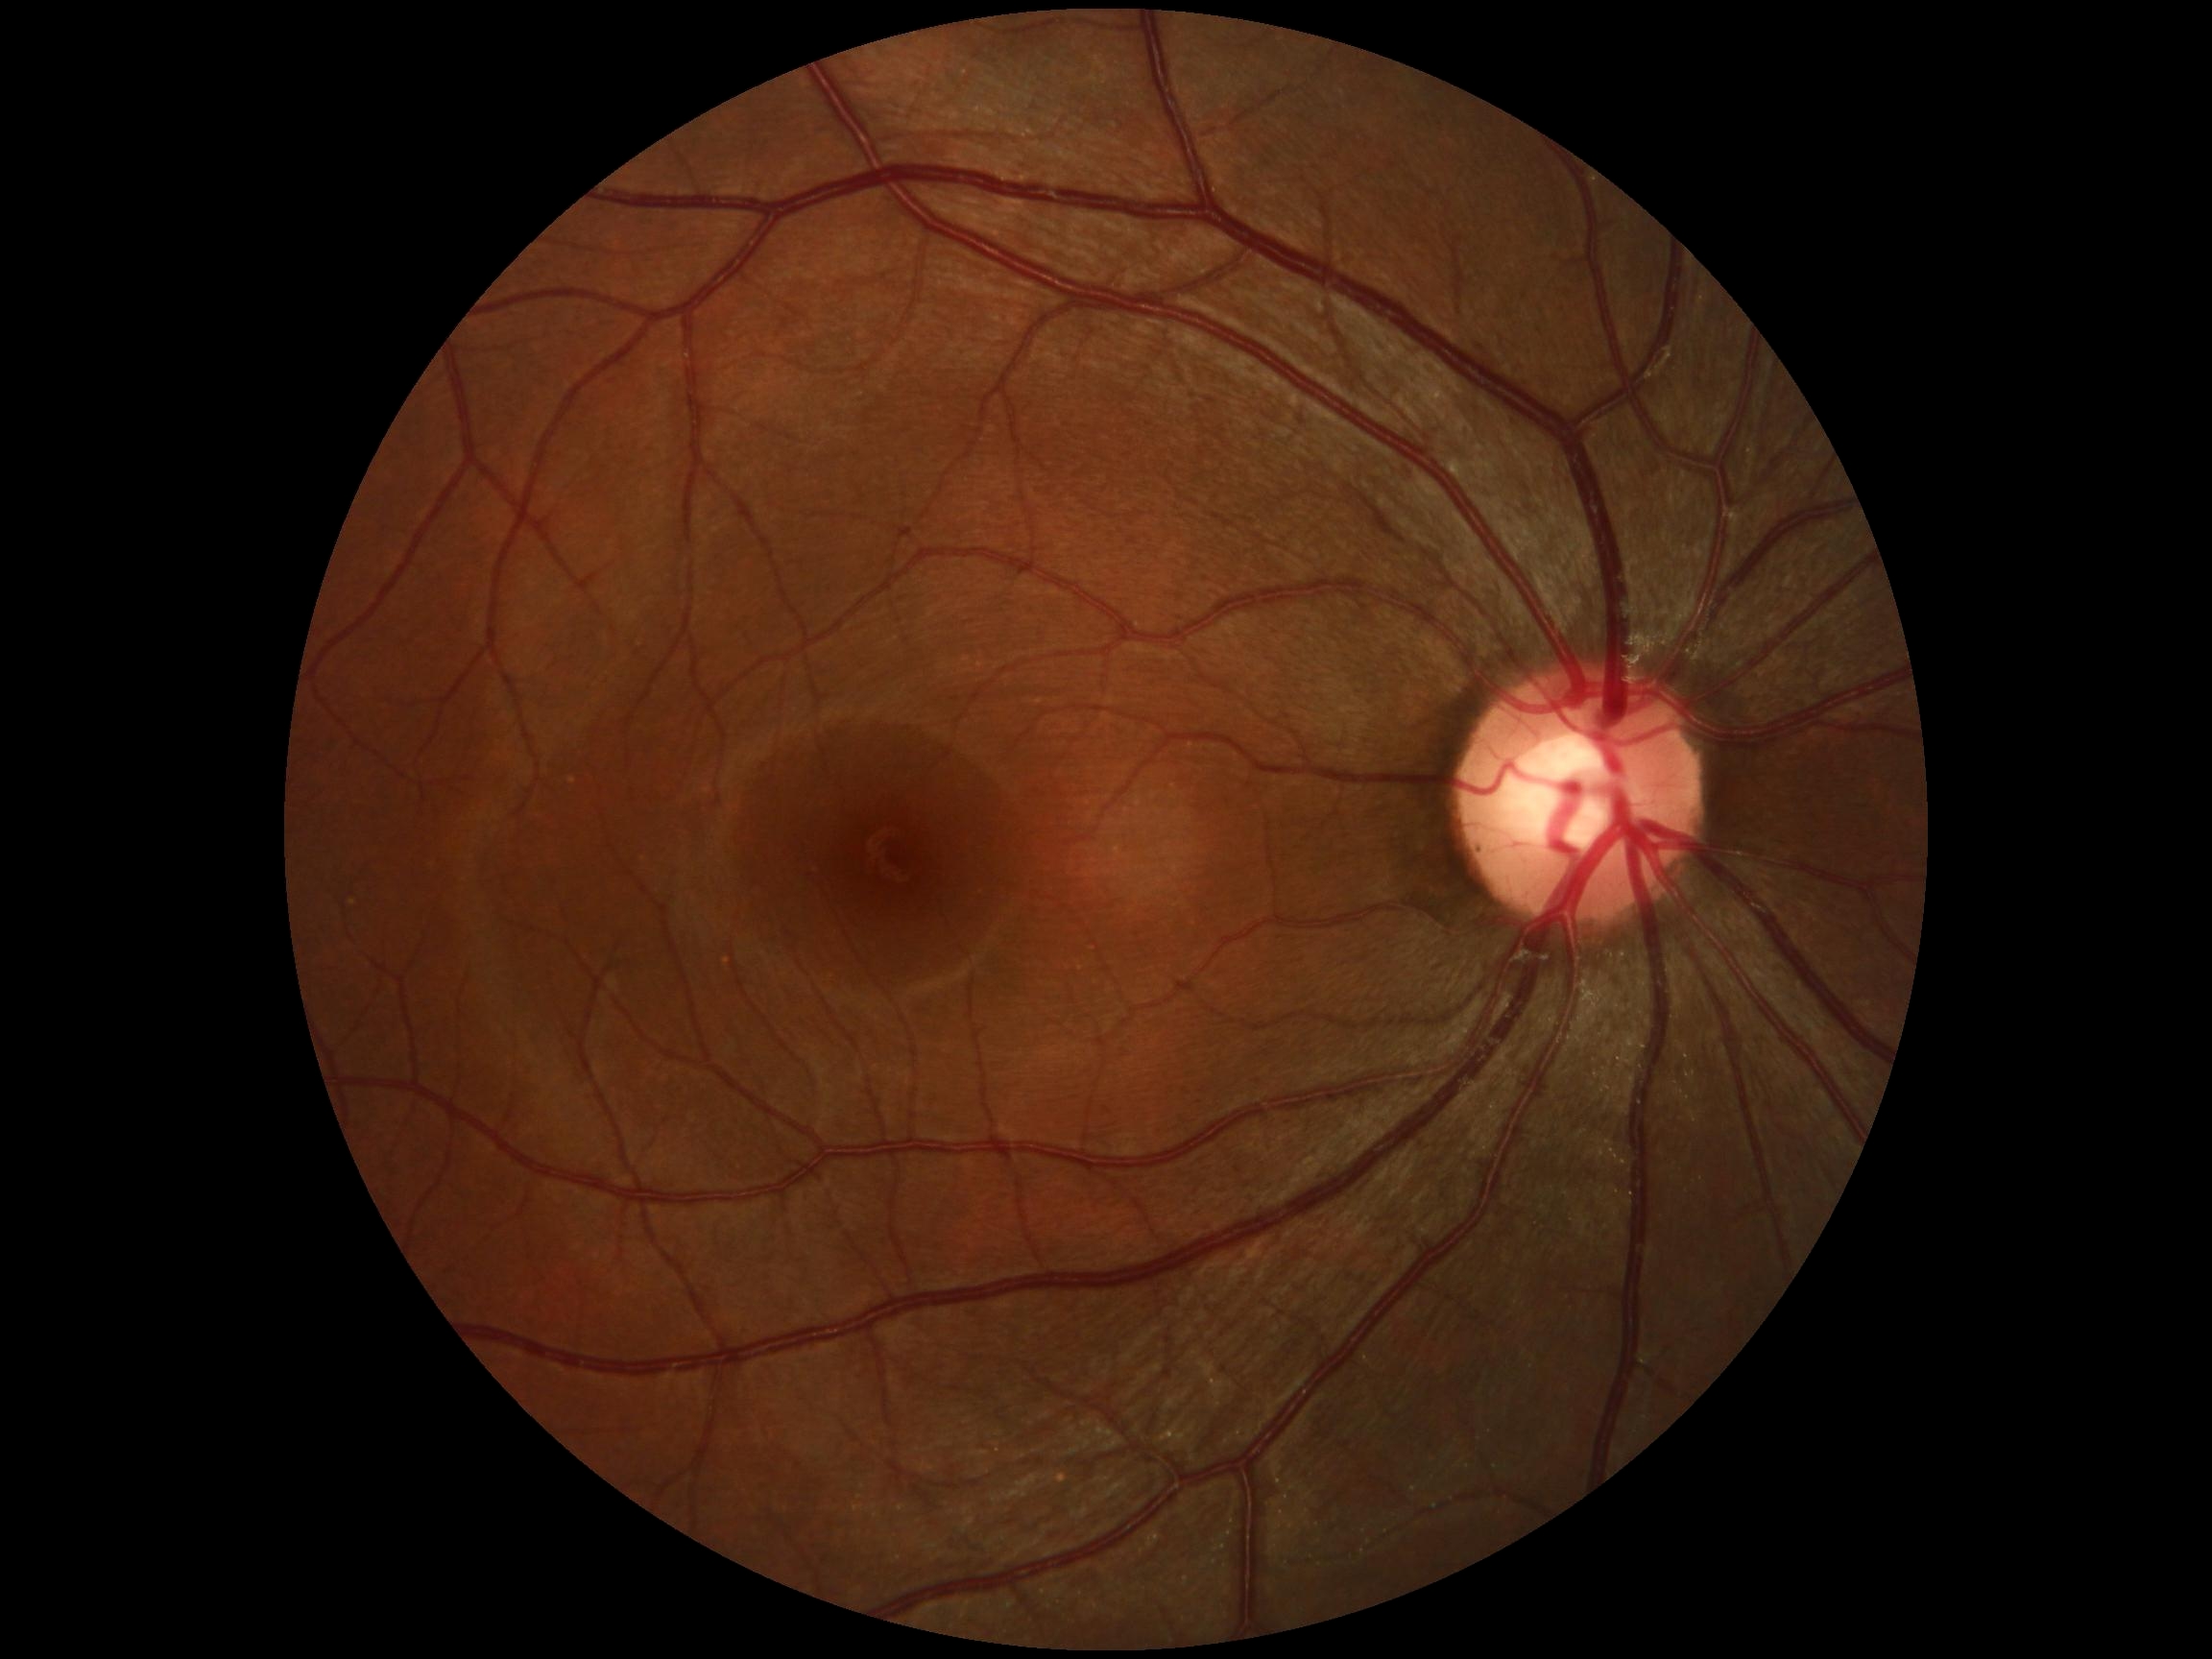 Annotations:
* diabetic retinopathy (DR) — 0/4 — no visible signs of diabetic retinopathy
* DR impression — no signs of DR